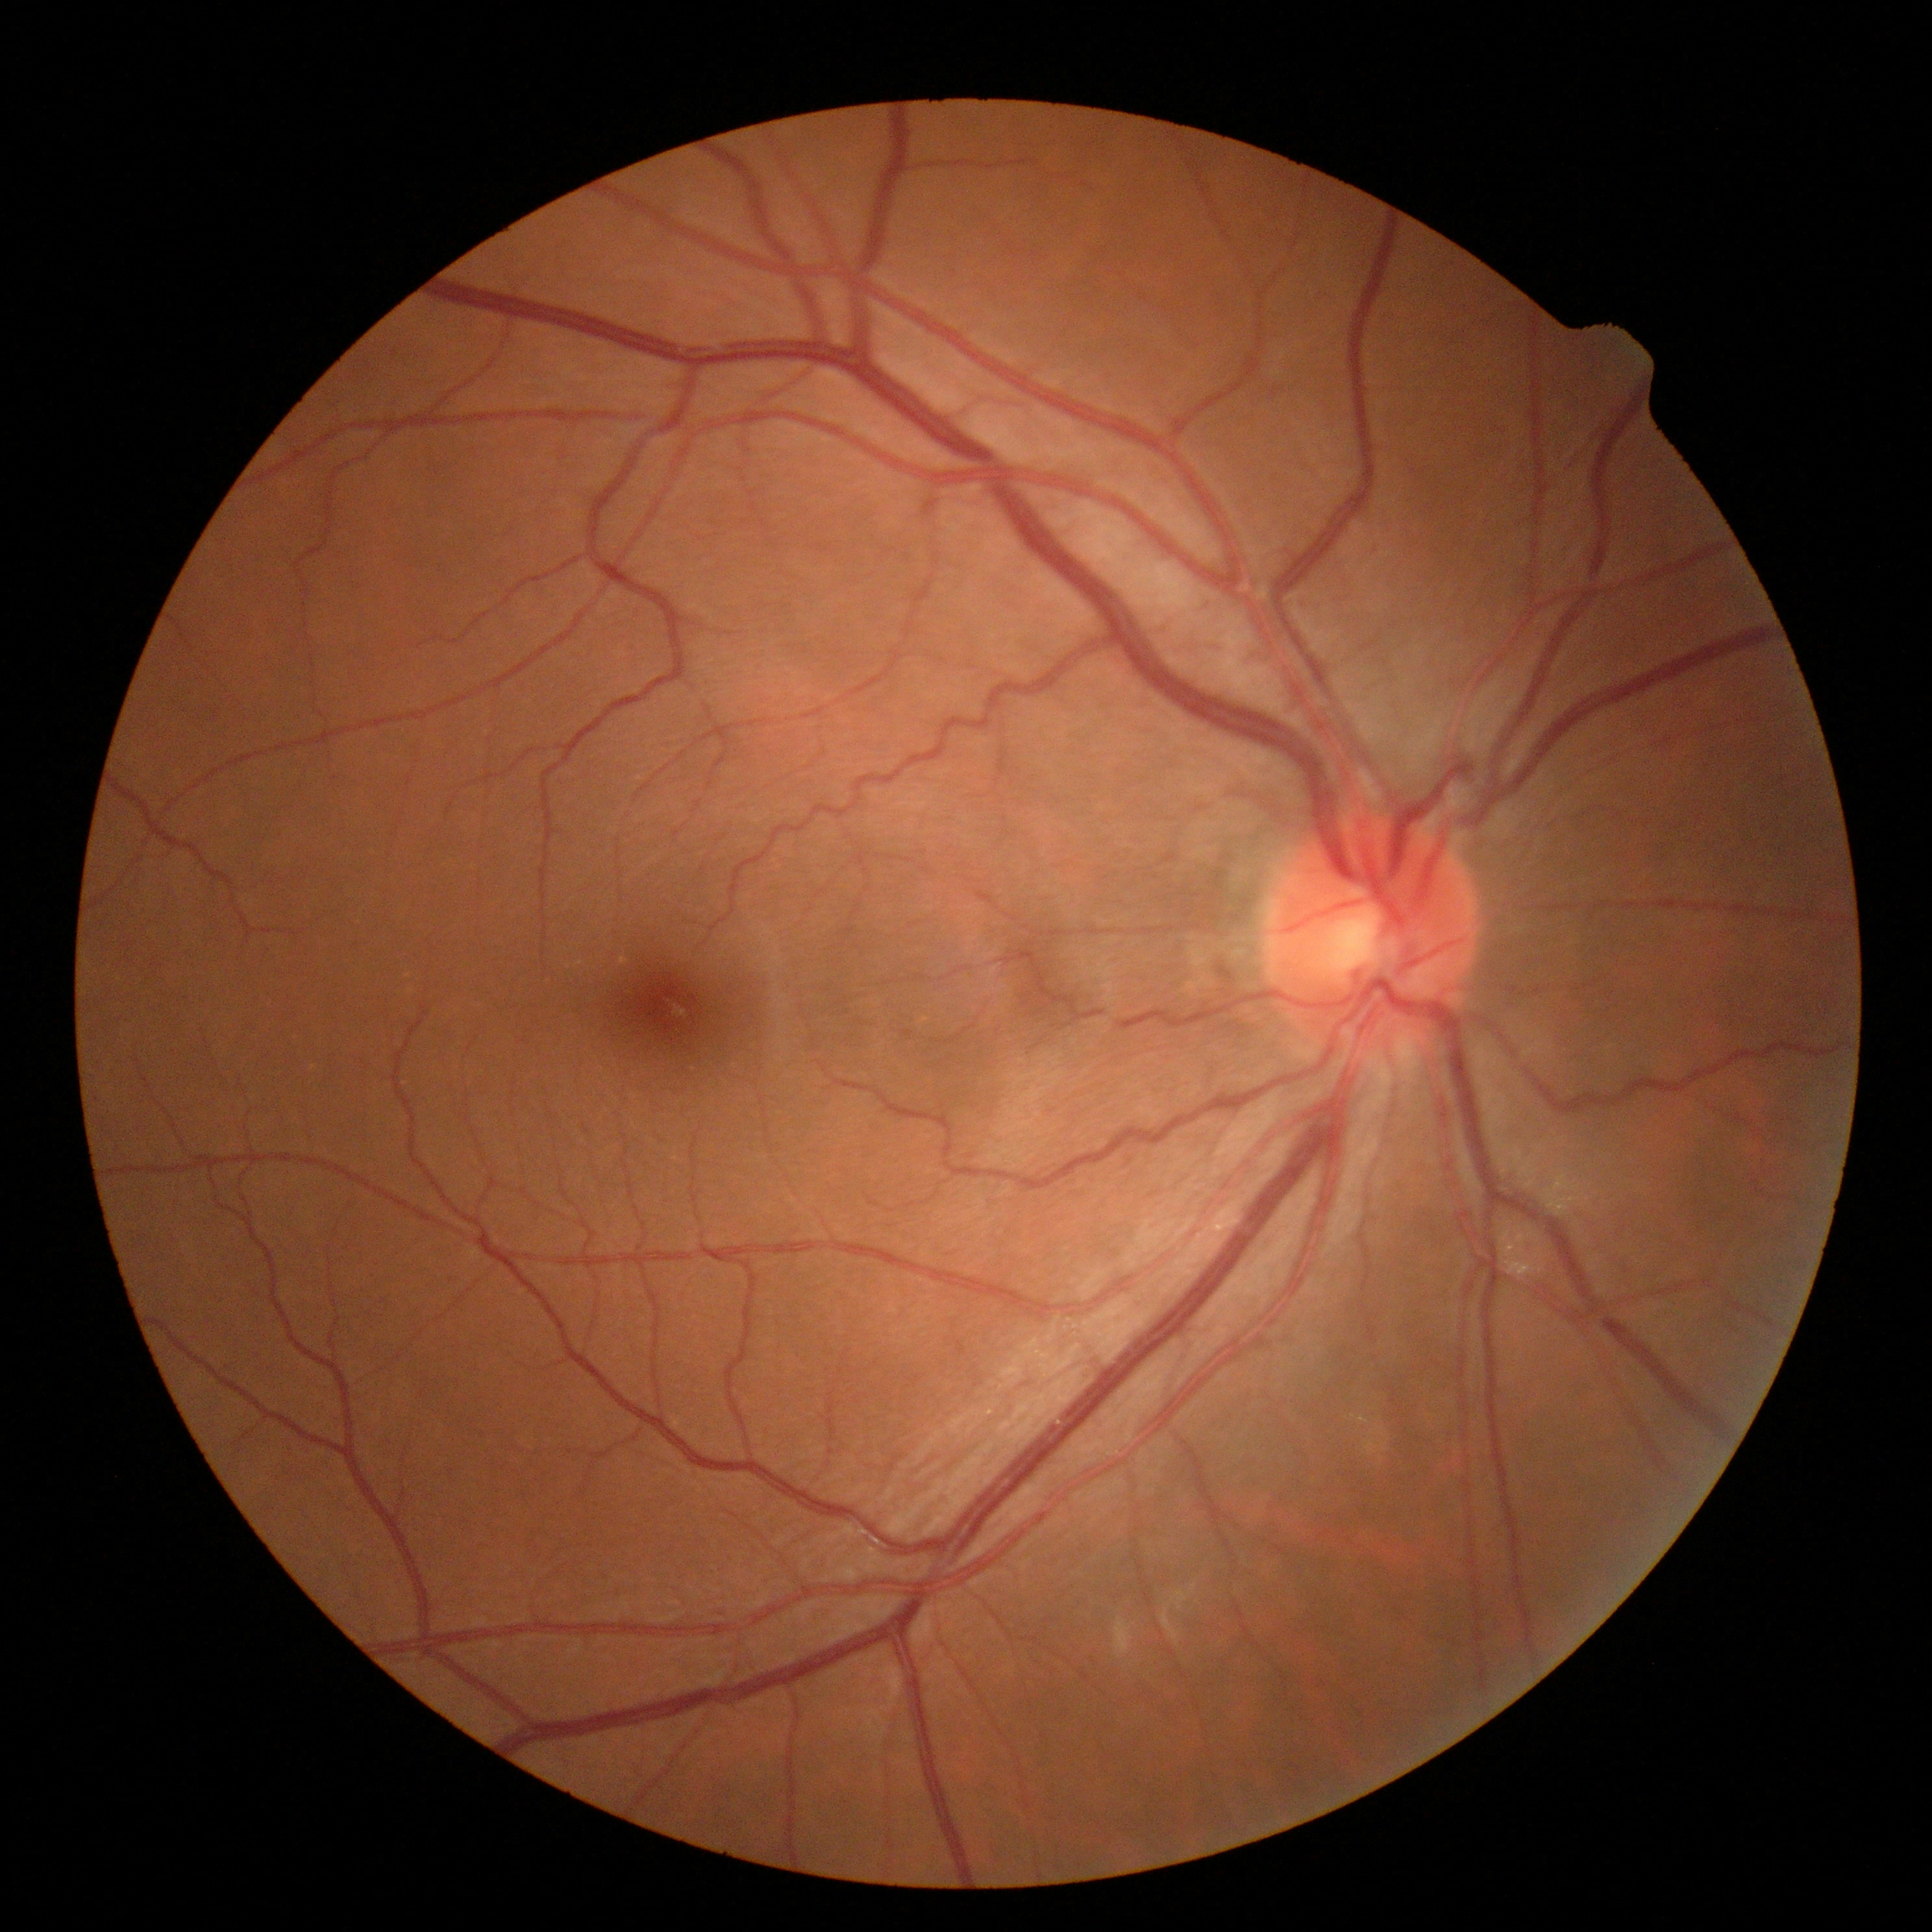
DR stage is grade 0 (no apparent retinopathy) — no visible signs of diabetic retinopathy.